45° FOV · image size 2352x1568 · color fundus image
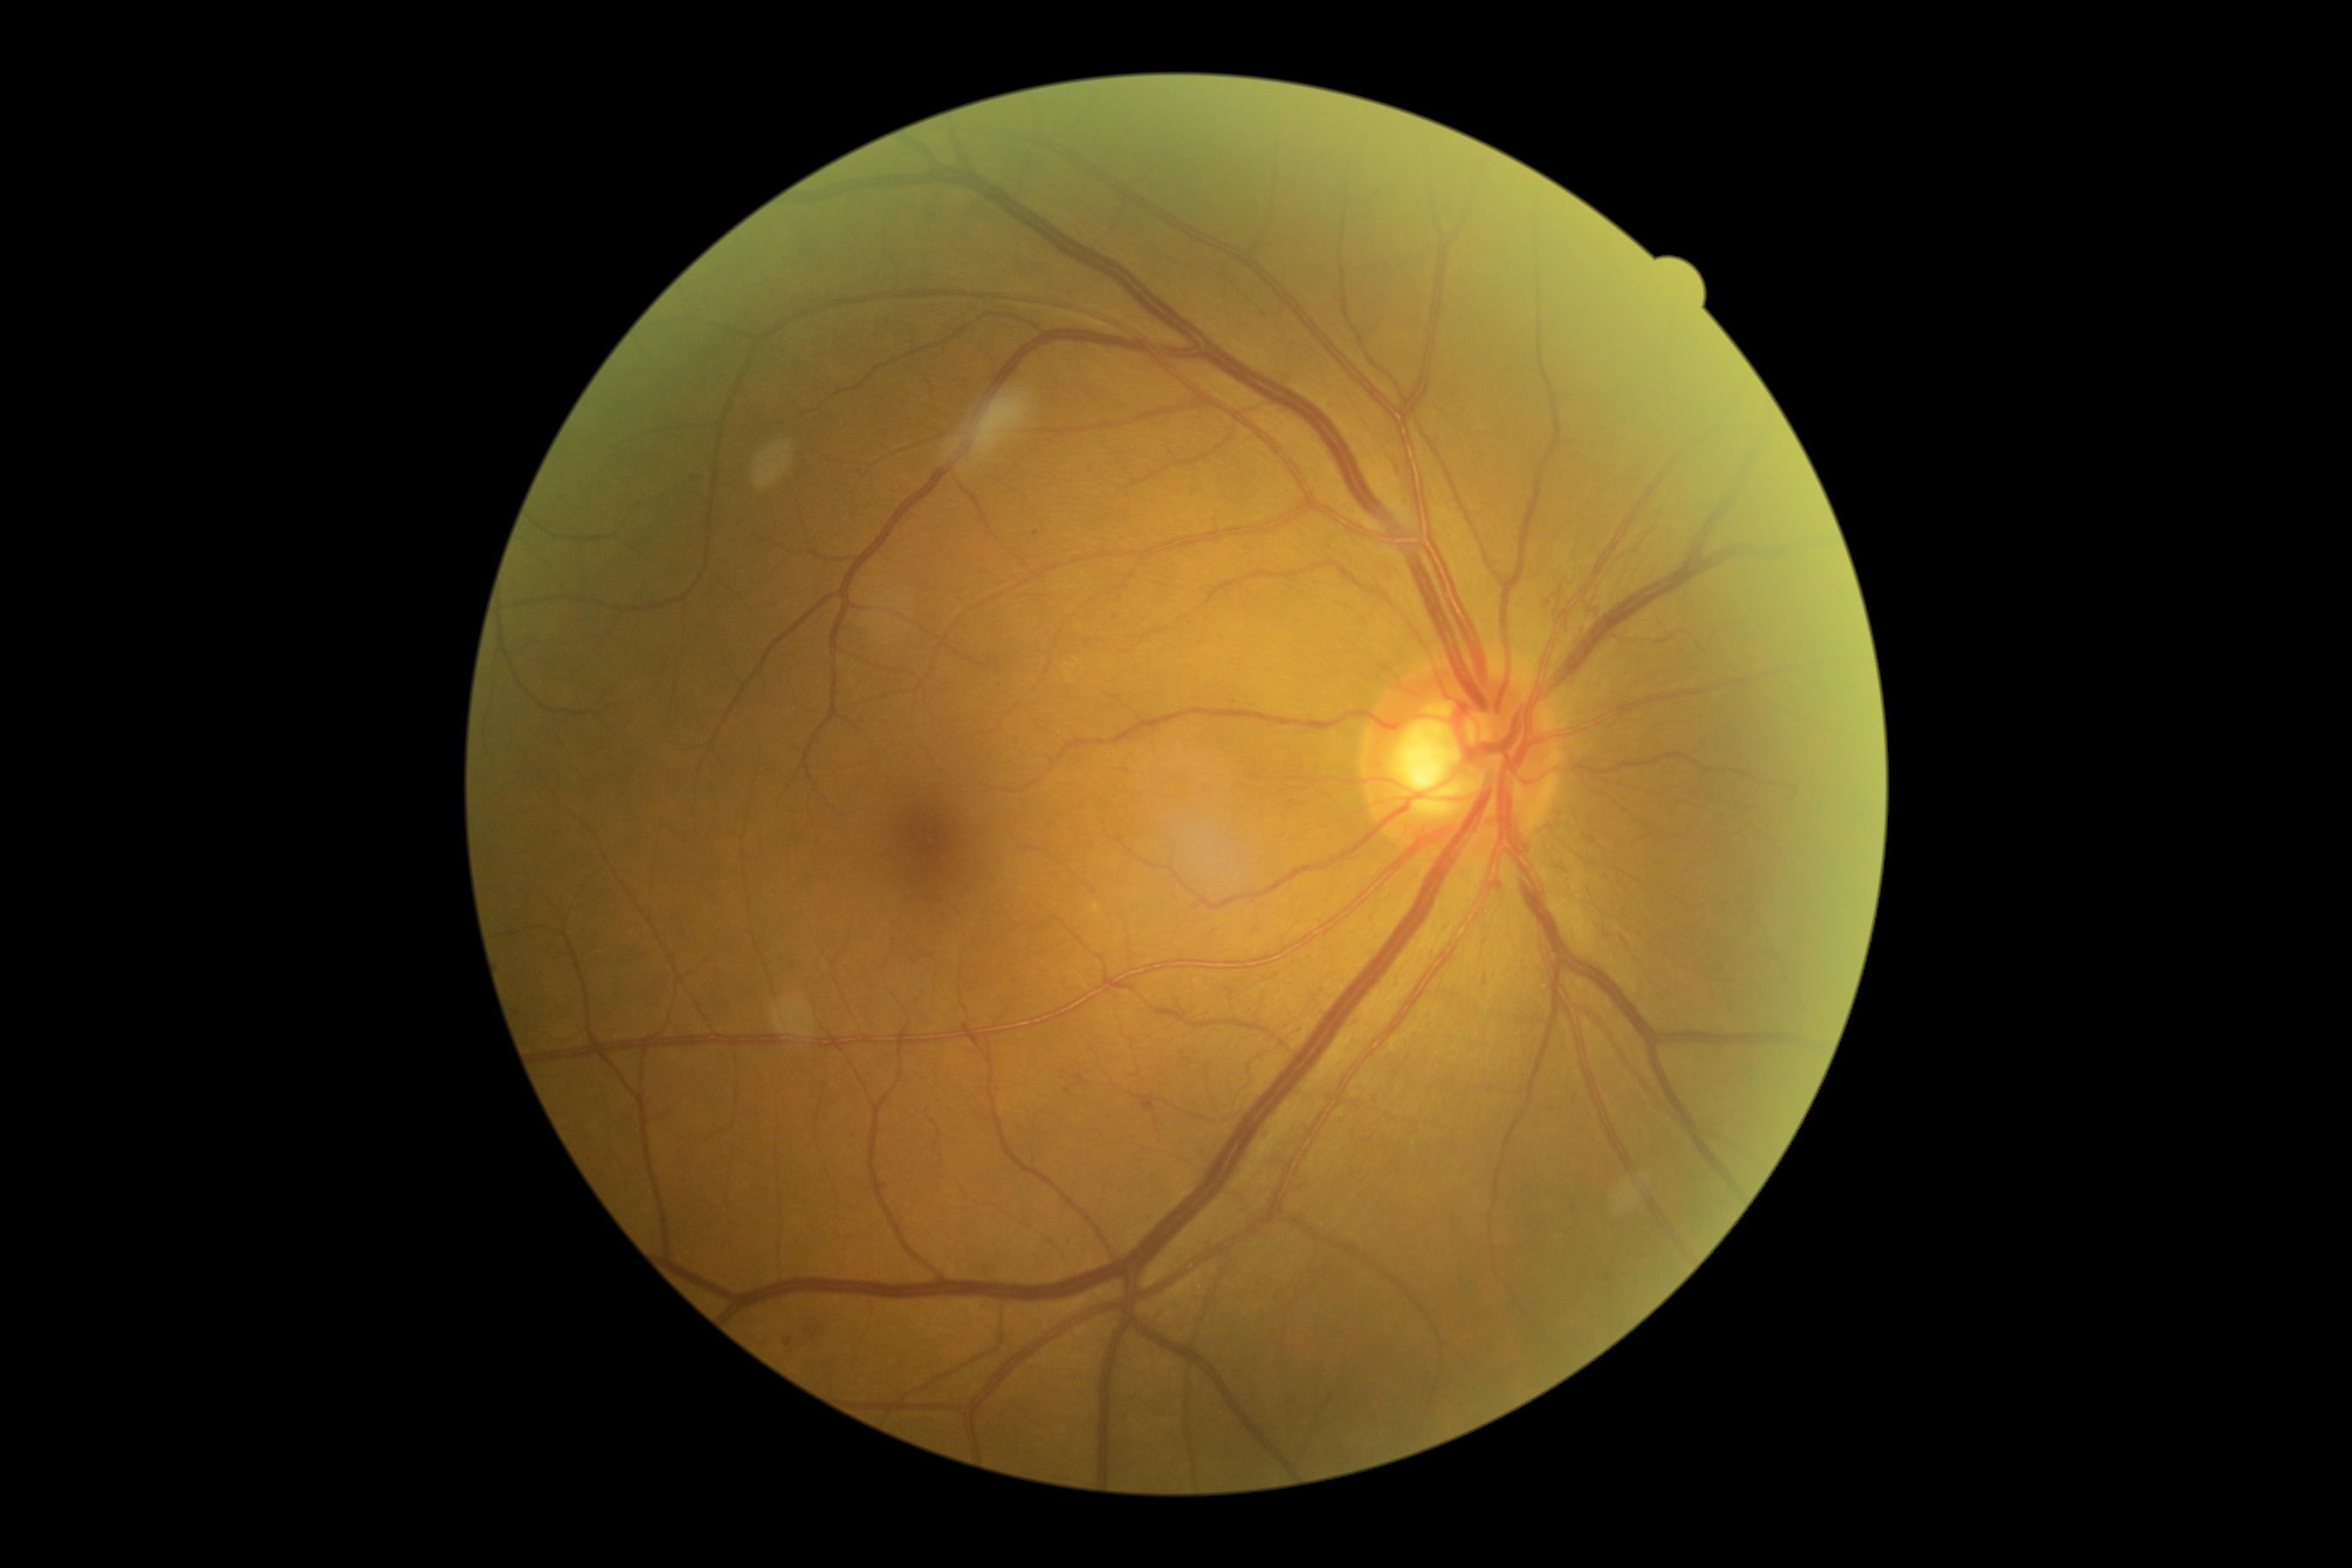

dr_grade: moderate NPDR (2)